CFP: 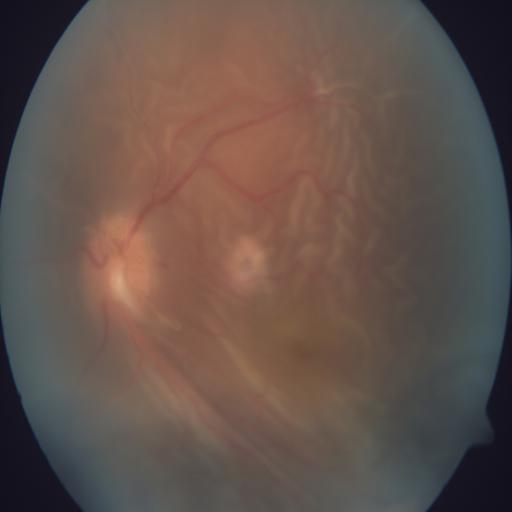 Pathology: retinal detachment.